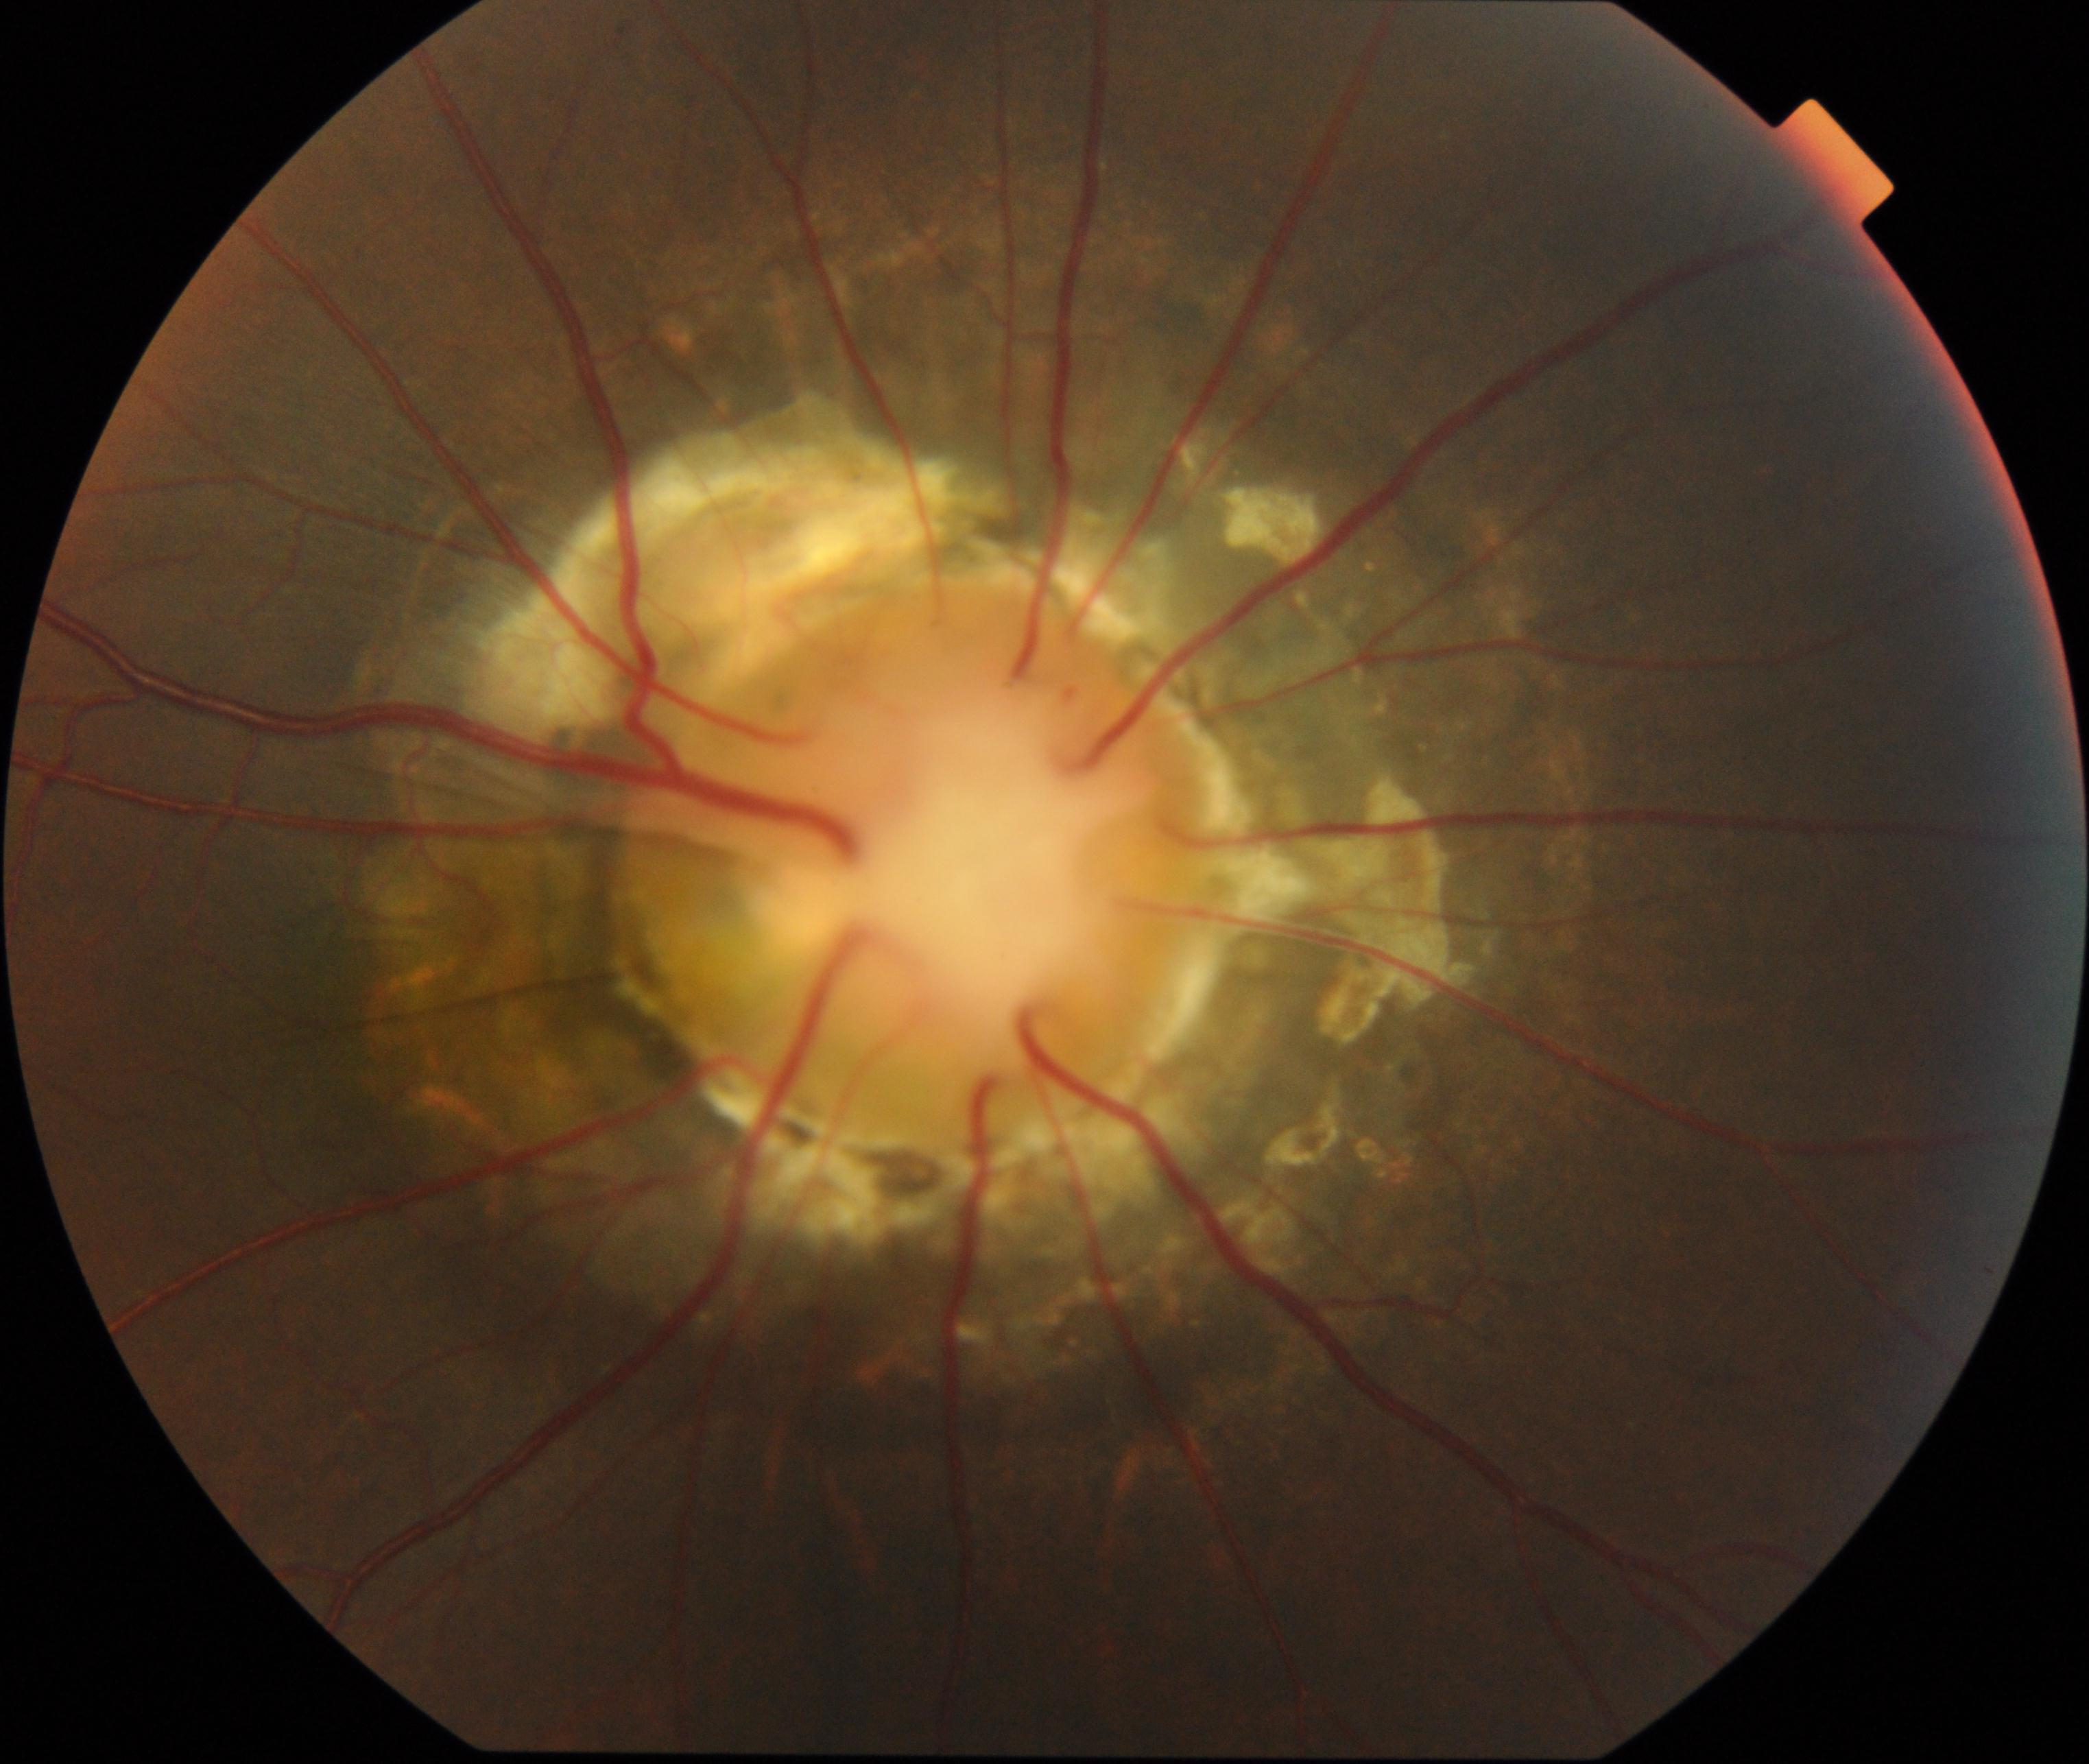

Impression: congenital disc abnormality.